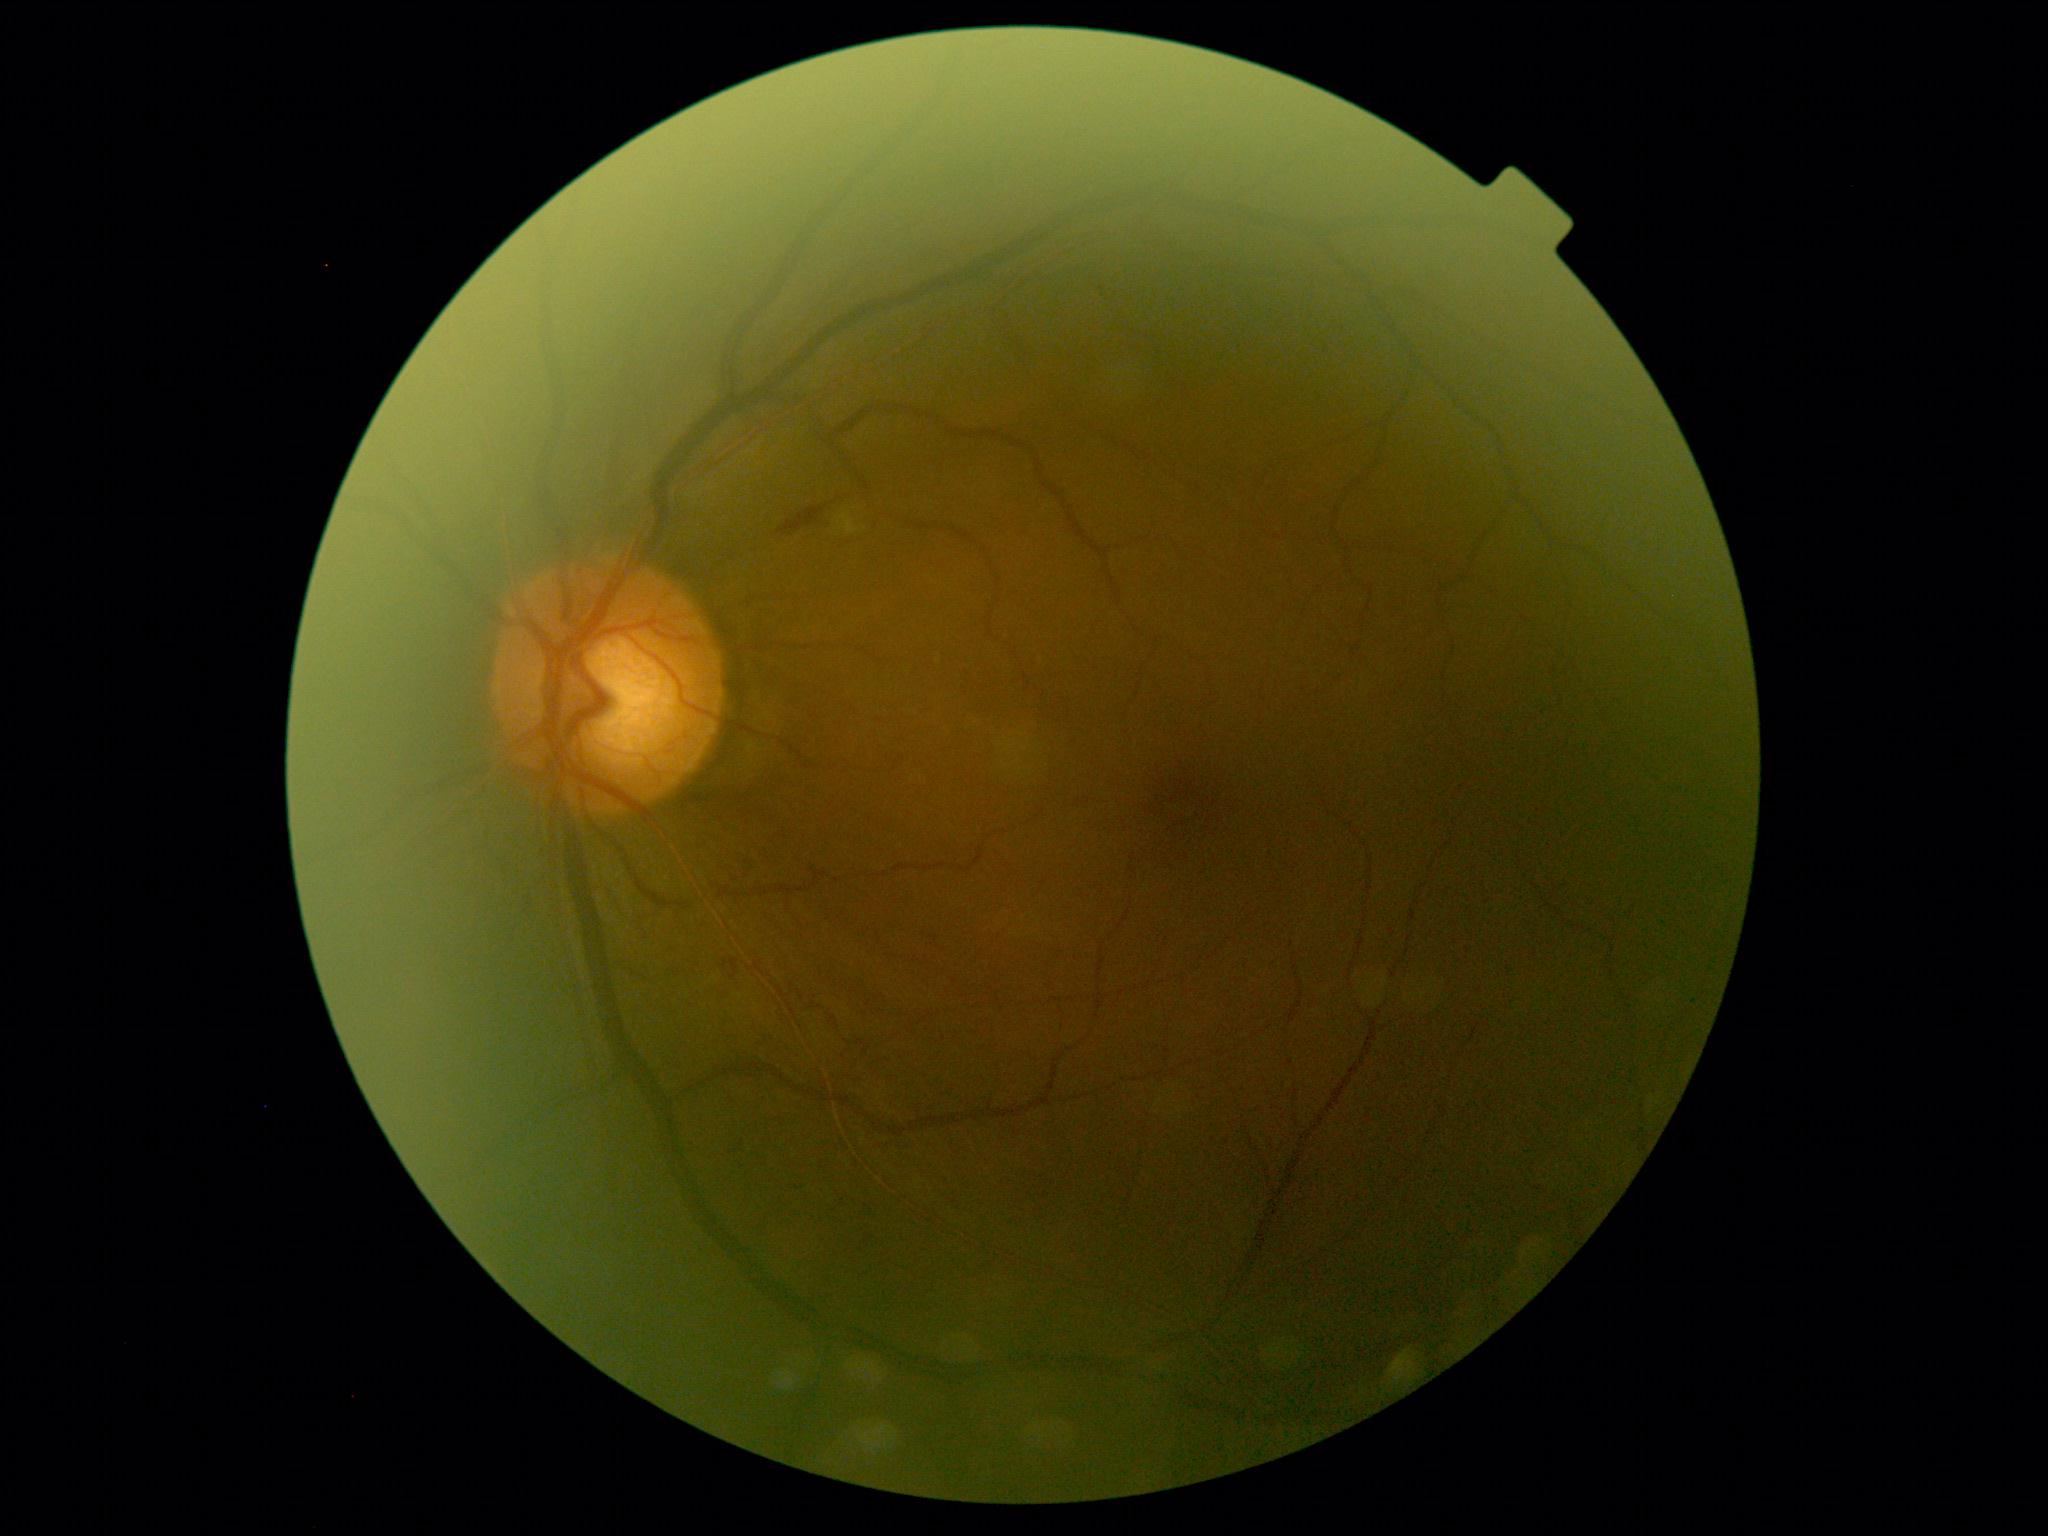 DR stage: 2/4 — more than just microaneurysms but less than severe NPDR.